Image size 240x240.
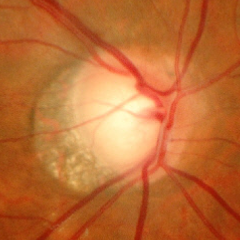

Optic disc photograph demonstrating early glaucoma.